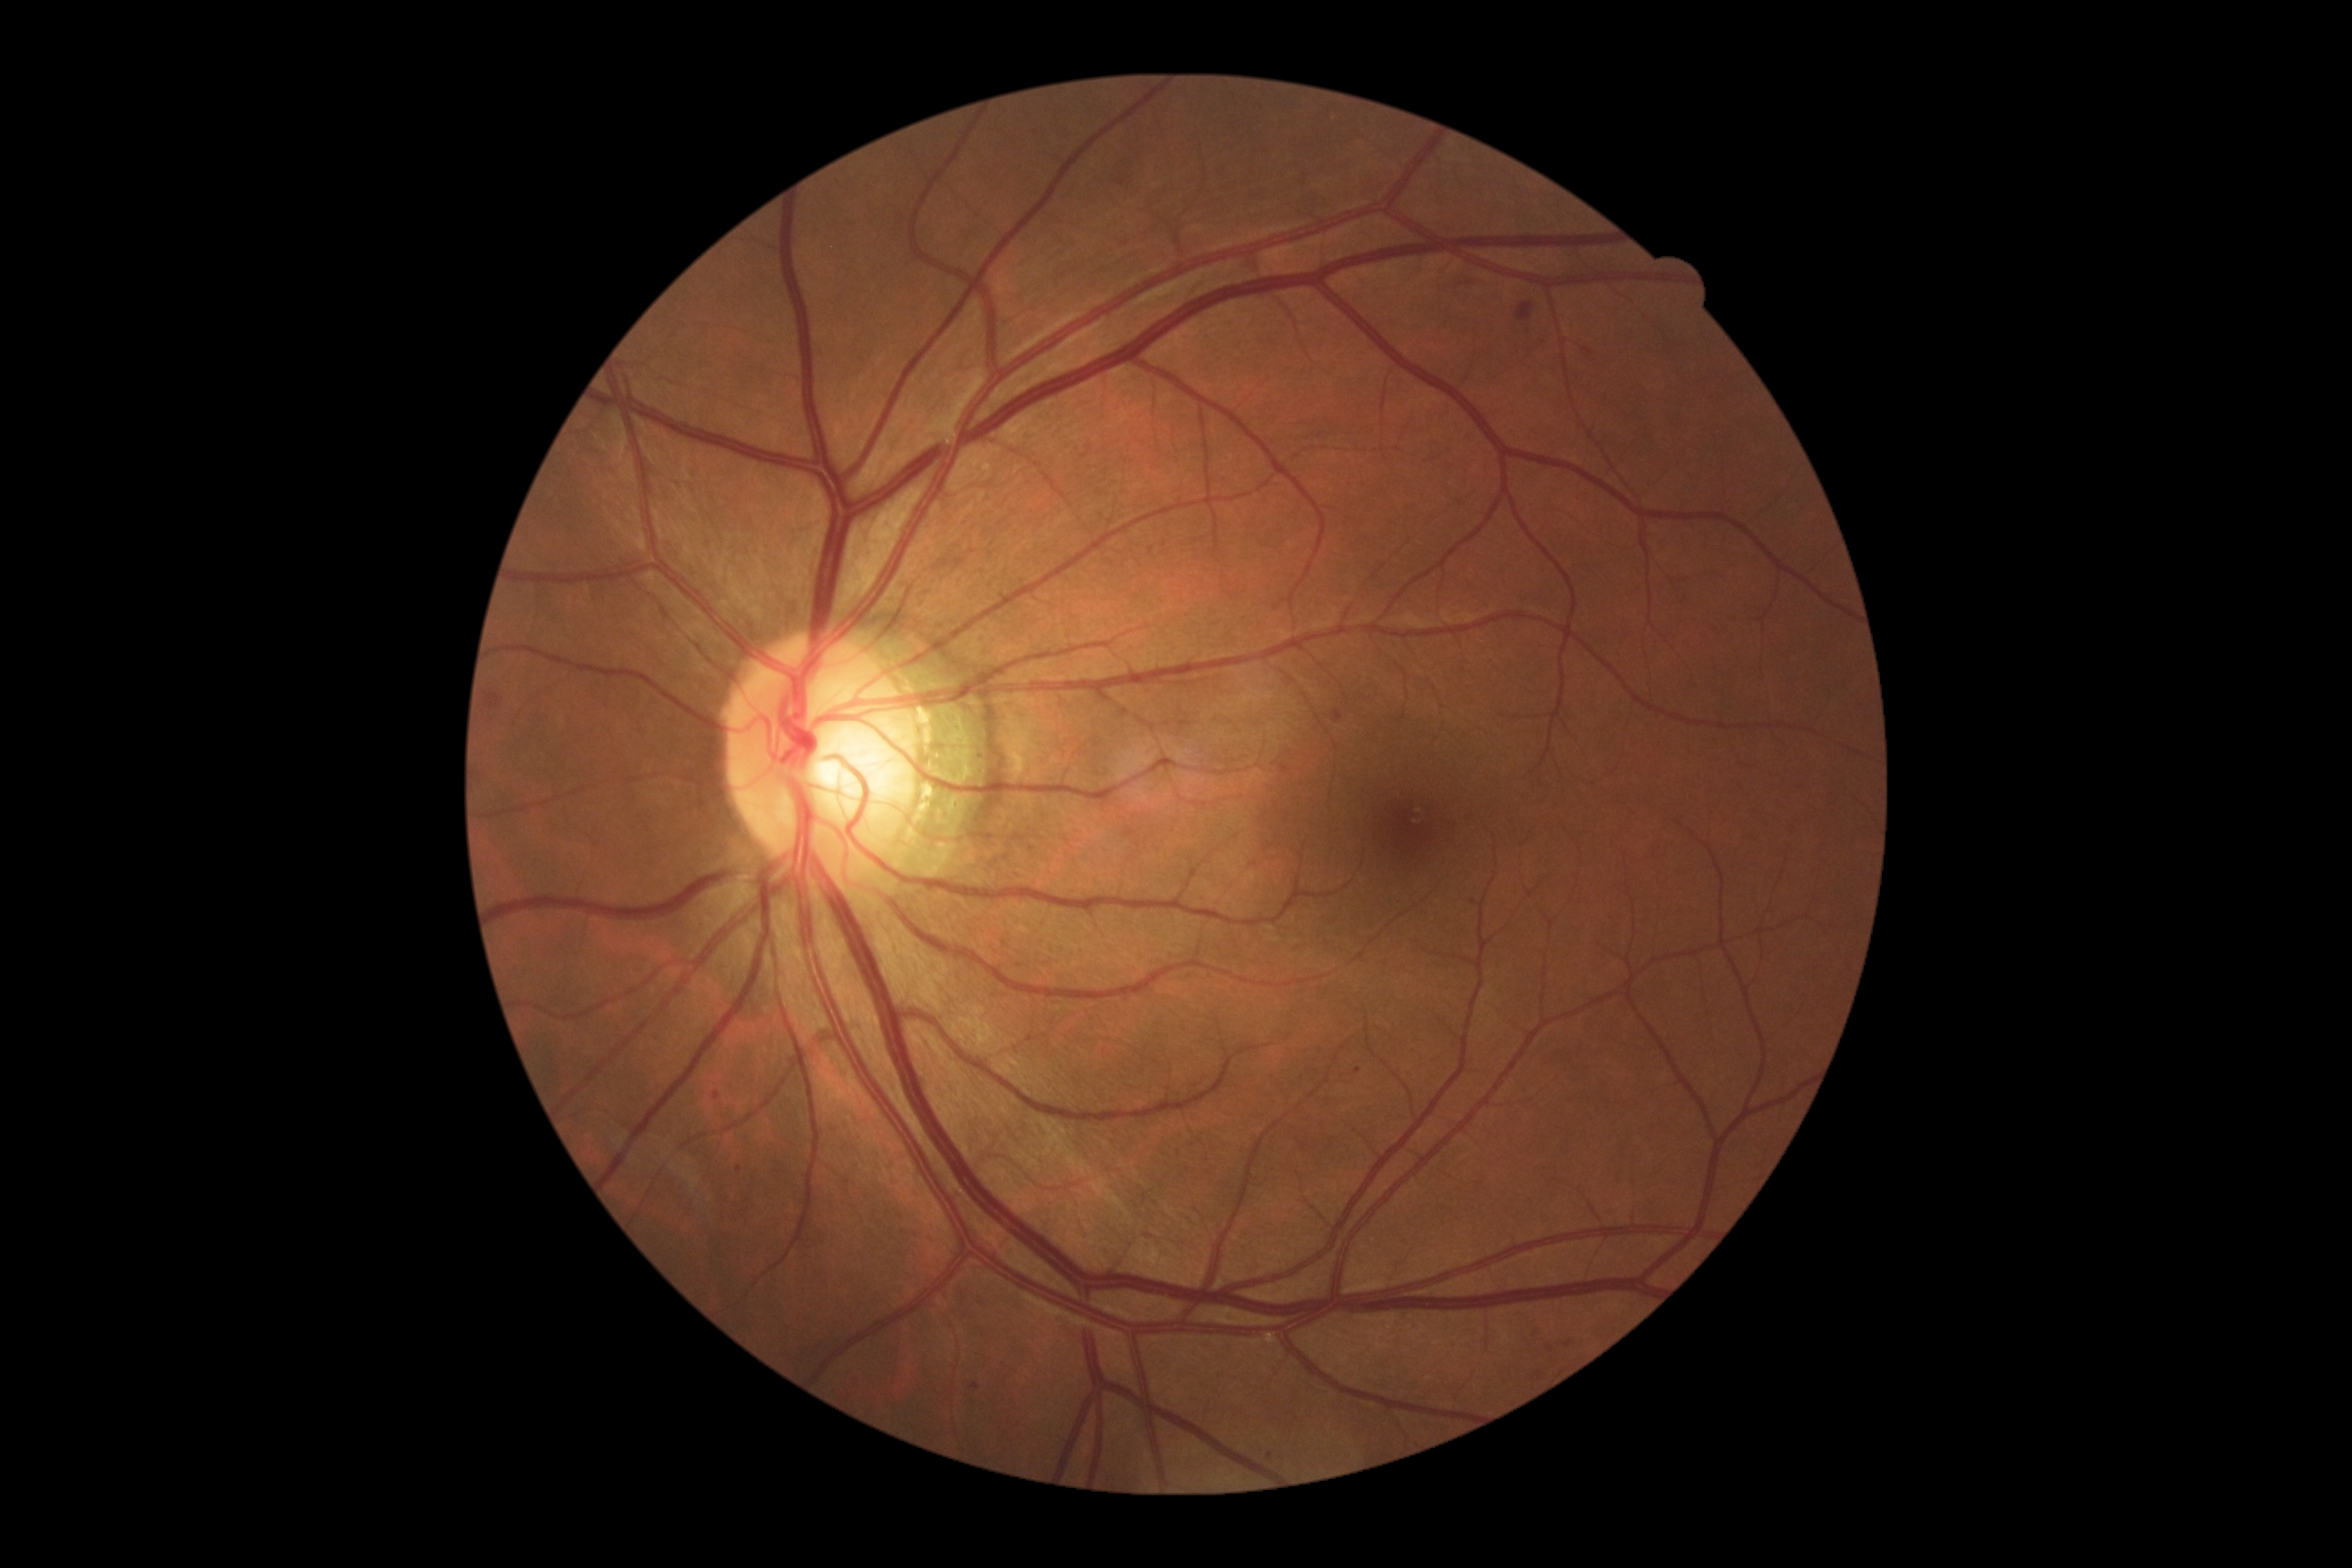
<lesions>
  <dr_grade>2</dr_grade>
  <ex />
  <ma>rect(712, 1092, 720, 1101), rect(972, 1384, 981, 1391)</ma>
  <ma_small>[1358, 1071], [739, 1171], [1270, 1456]</ma_small>
  <he>rect(485, 694, 502, 710), rect(1565, 1340, 1574, 1348), rect(1516, 302, 1534, 320), rect(1536, 1326, 1547, 1335), rect(1333, 710, 1344, 723)</he>
  <he_small>[1550, 1349]</he_small>
  <se />
</lesions>